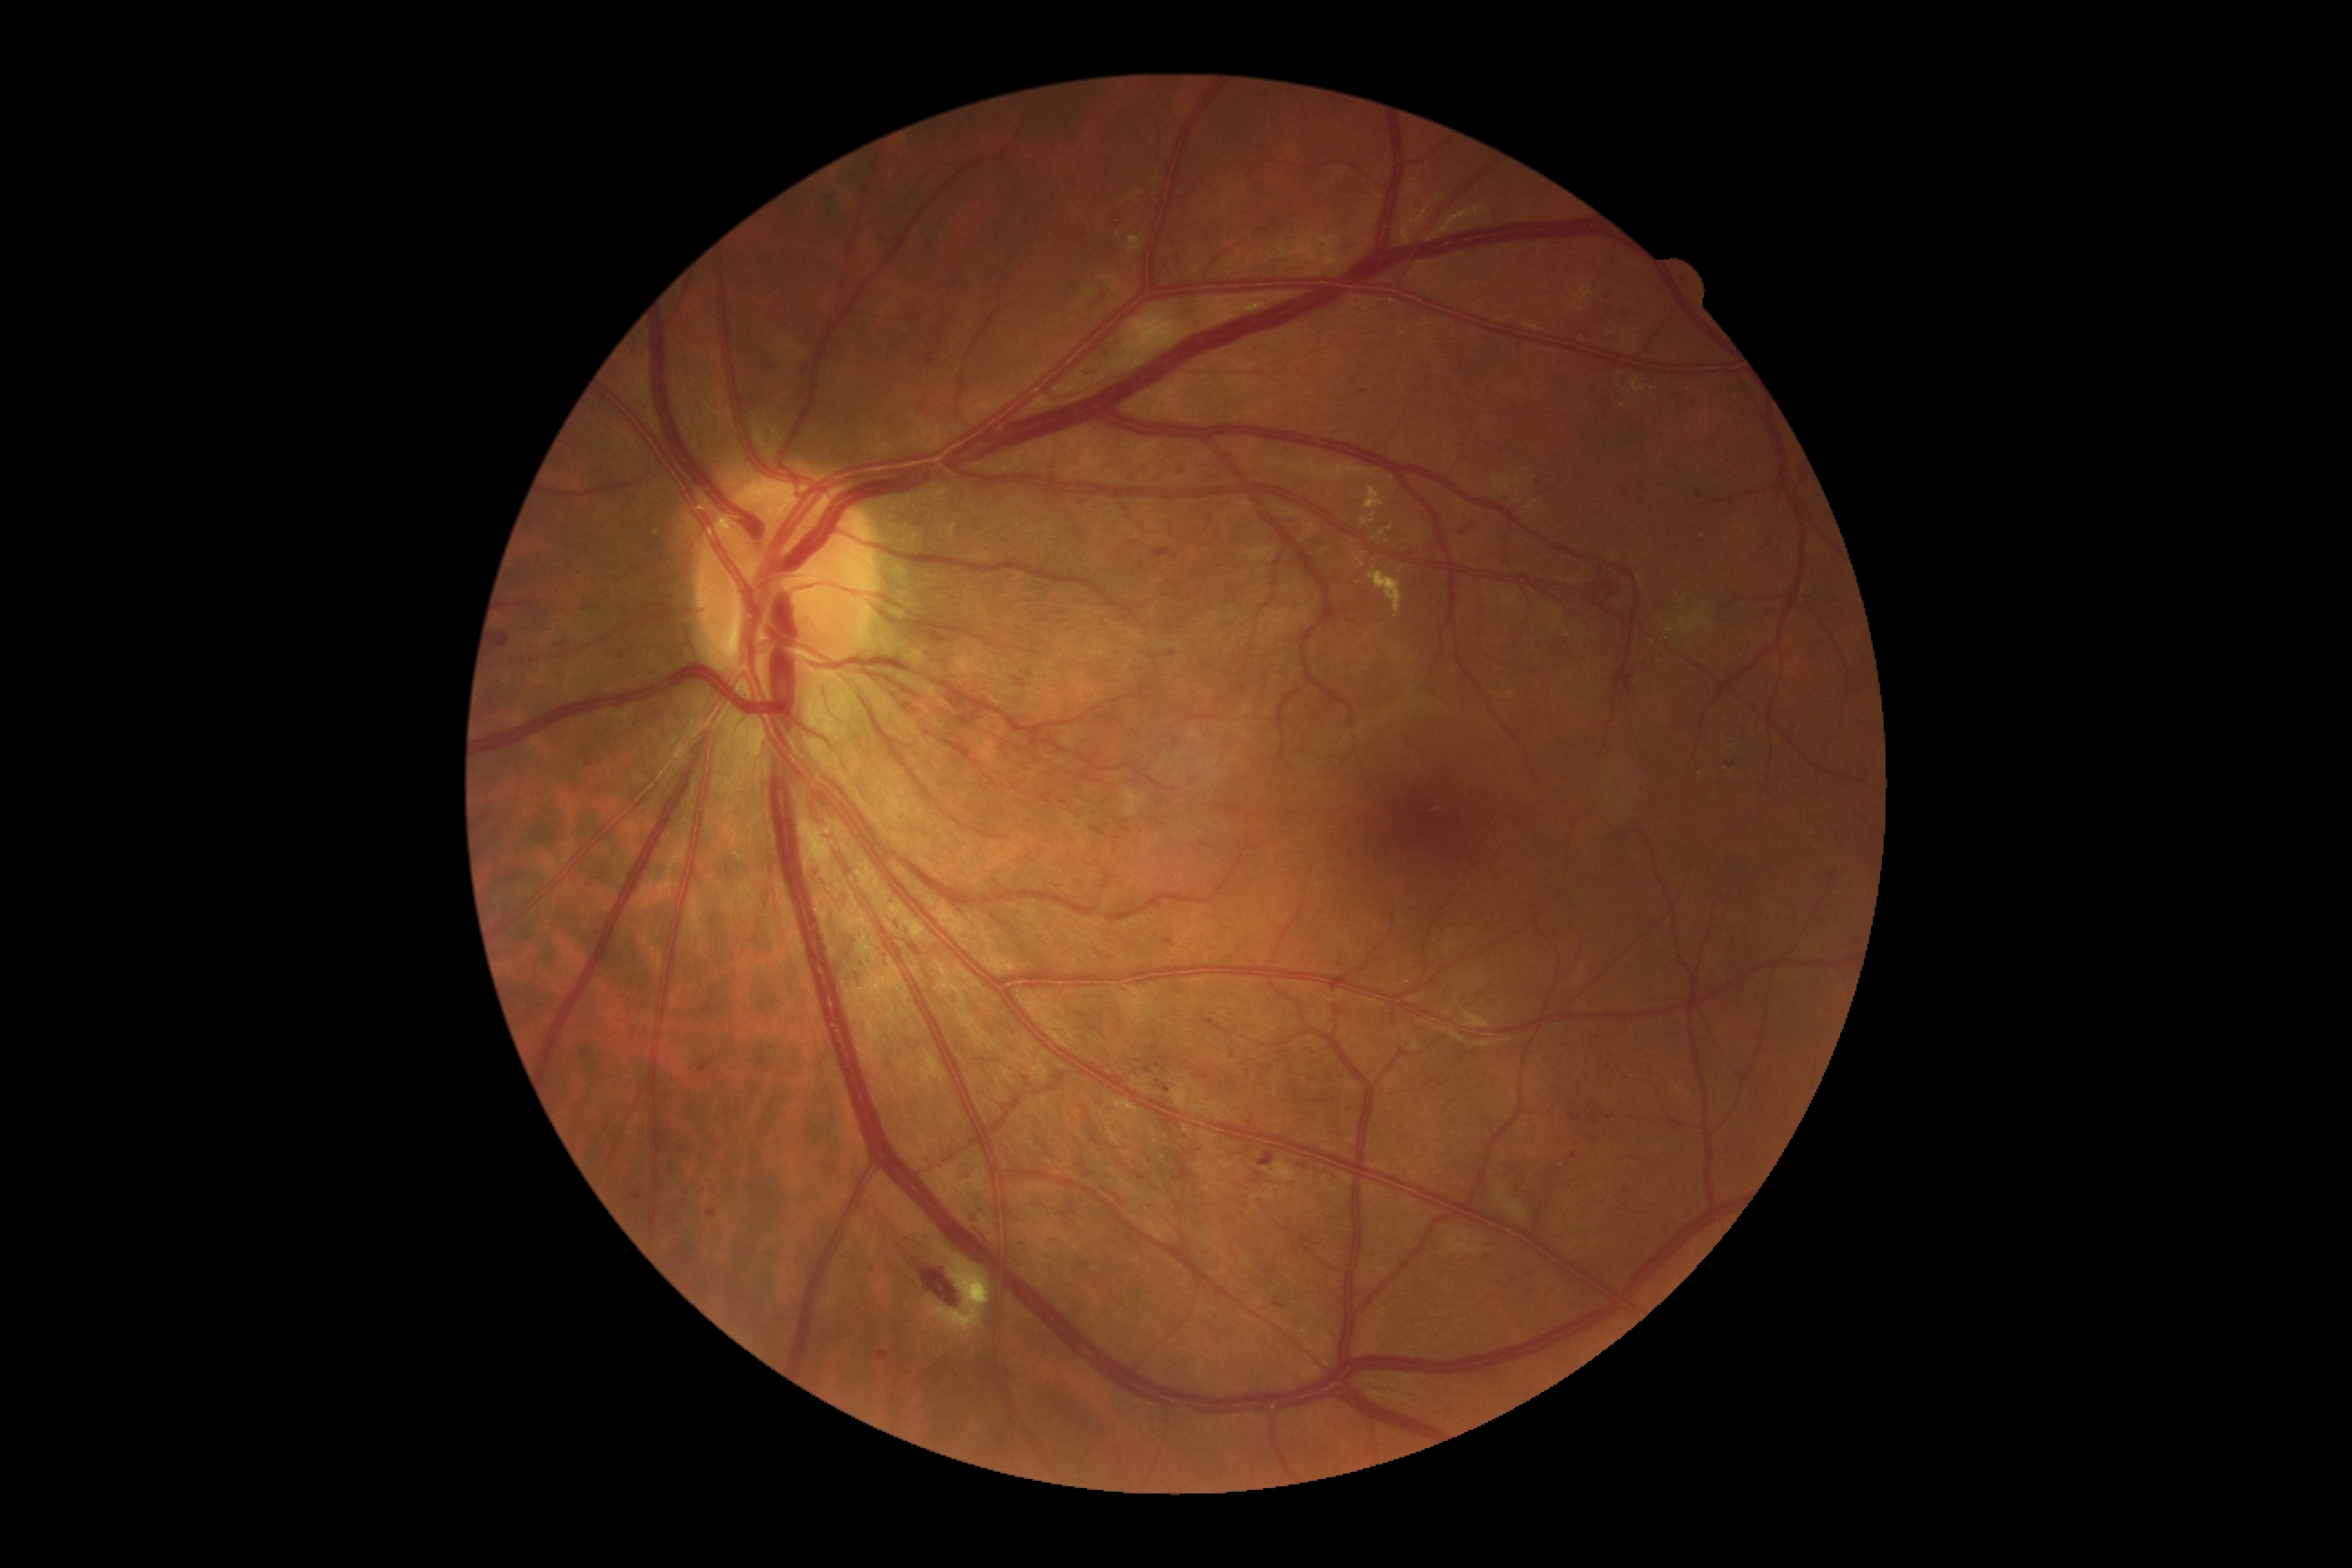

Diabetic retinopathy grade is 2 (moderate NPDR); non-proliferative diabetic retinopathy
Lesions identified (partial list):
hemorrhages (subset): <region>1144, 1066, 1152, 1073</region>, <region>495, 634, 511, 649</region>, <region>903, 926, 914, 936</region>, <region>1458, 520, 1476, 536</region>, <region>892, 917, 901, 934</region>, <region>585, 758, 593, 769</region>, <region>1168, 652, 1177, 658</region>, <region>1589, 1102, 1600, 1112</region>, <region>910, 945, 921, 956</region>, <region>1079, 230, 1088, 237</region>, <region>1083, 368, 1102, 377</region>, <region>810, 867, 830, 894</region>, <region>923, 1155, 932, 1168</region>, <region>701, 1064, 710, 1073</region>, <region>1687, 398, 1700, 409</region>
Small hemorrhages approximately at (x=505, y=607), (x=1700, y=495), (x=1574, y=1156), (x=1169, y=943)